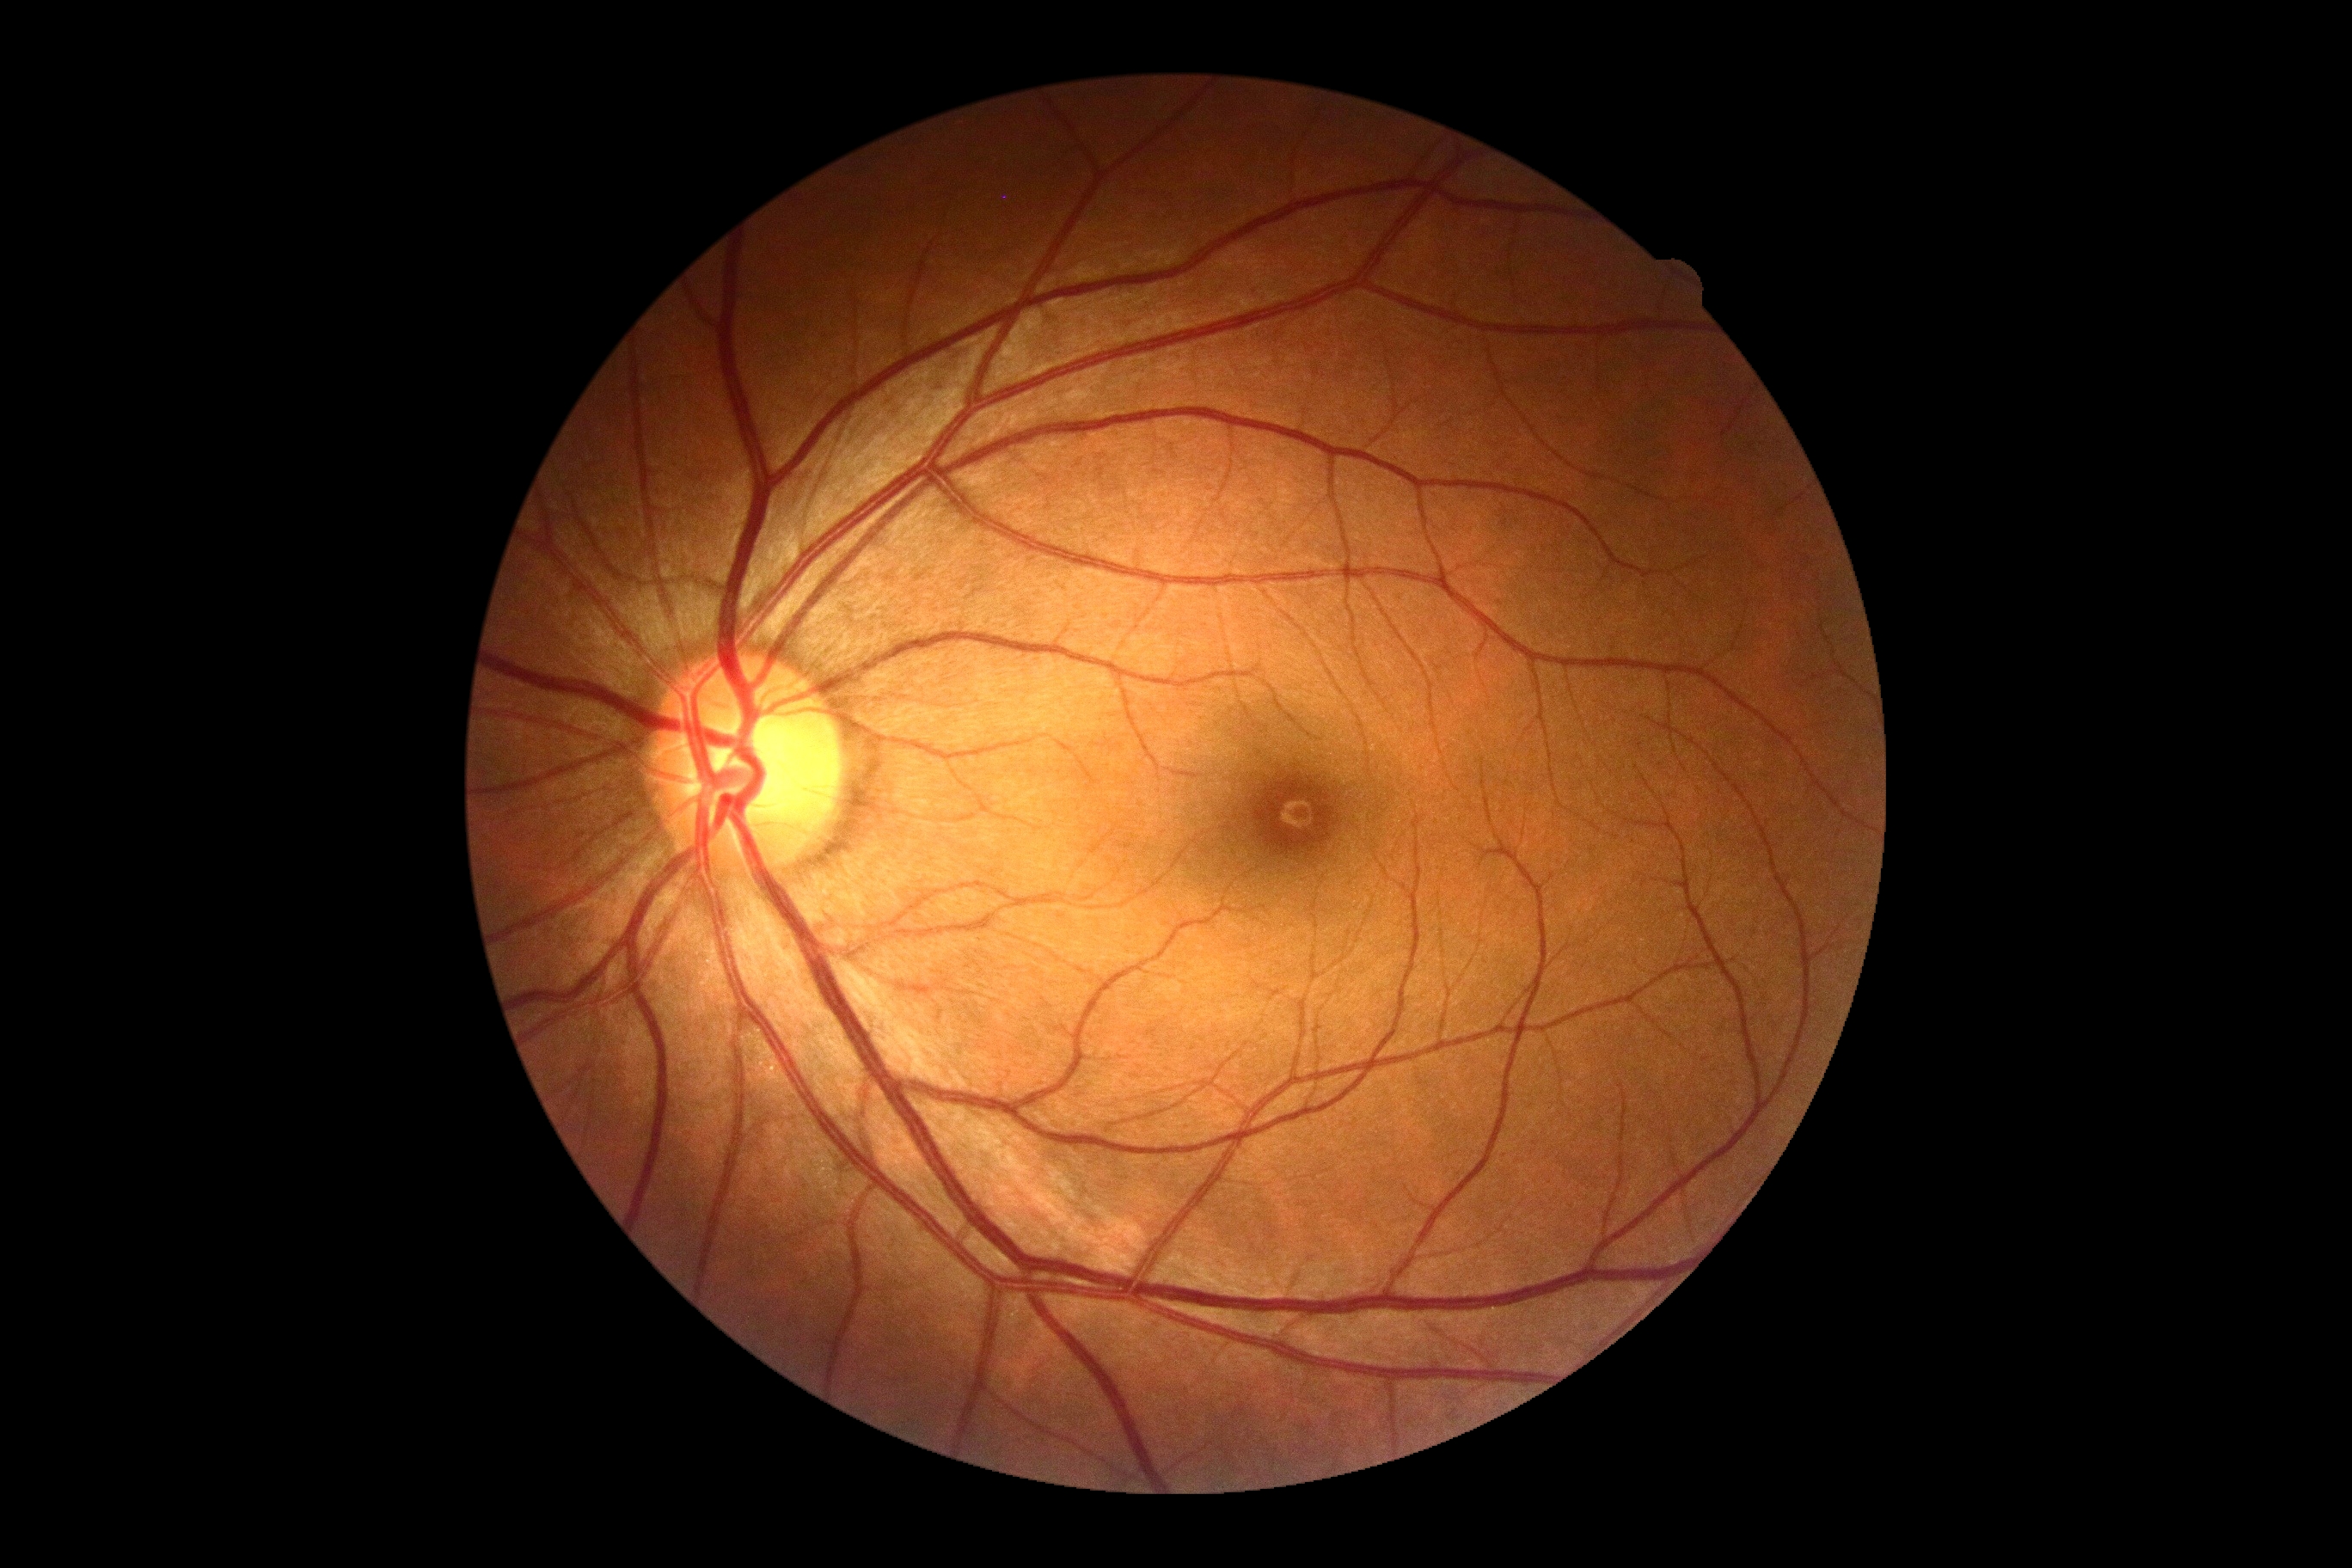
DR stage=0/4.